FOV: 45 degrees — 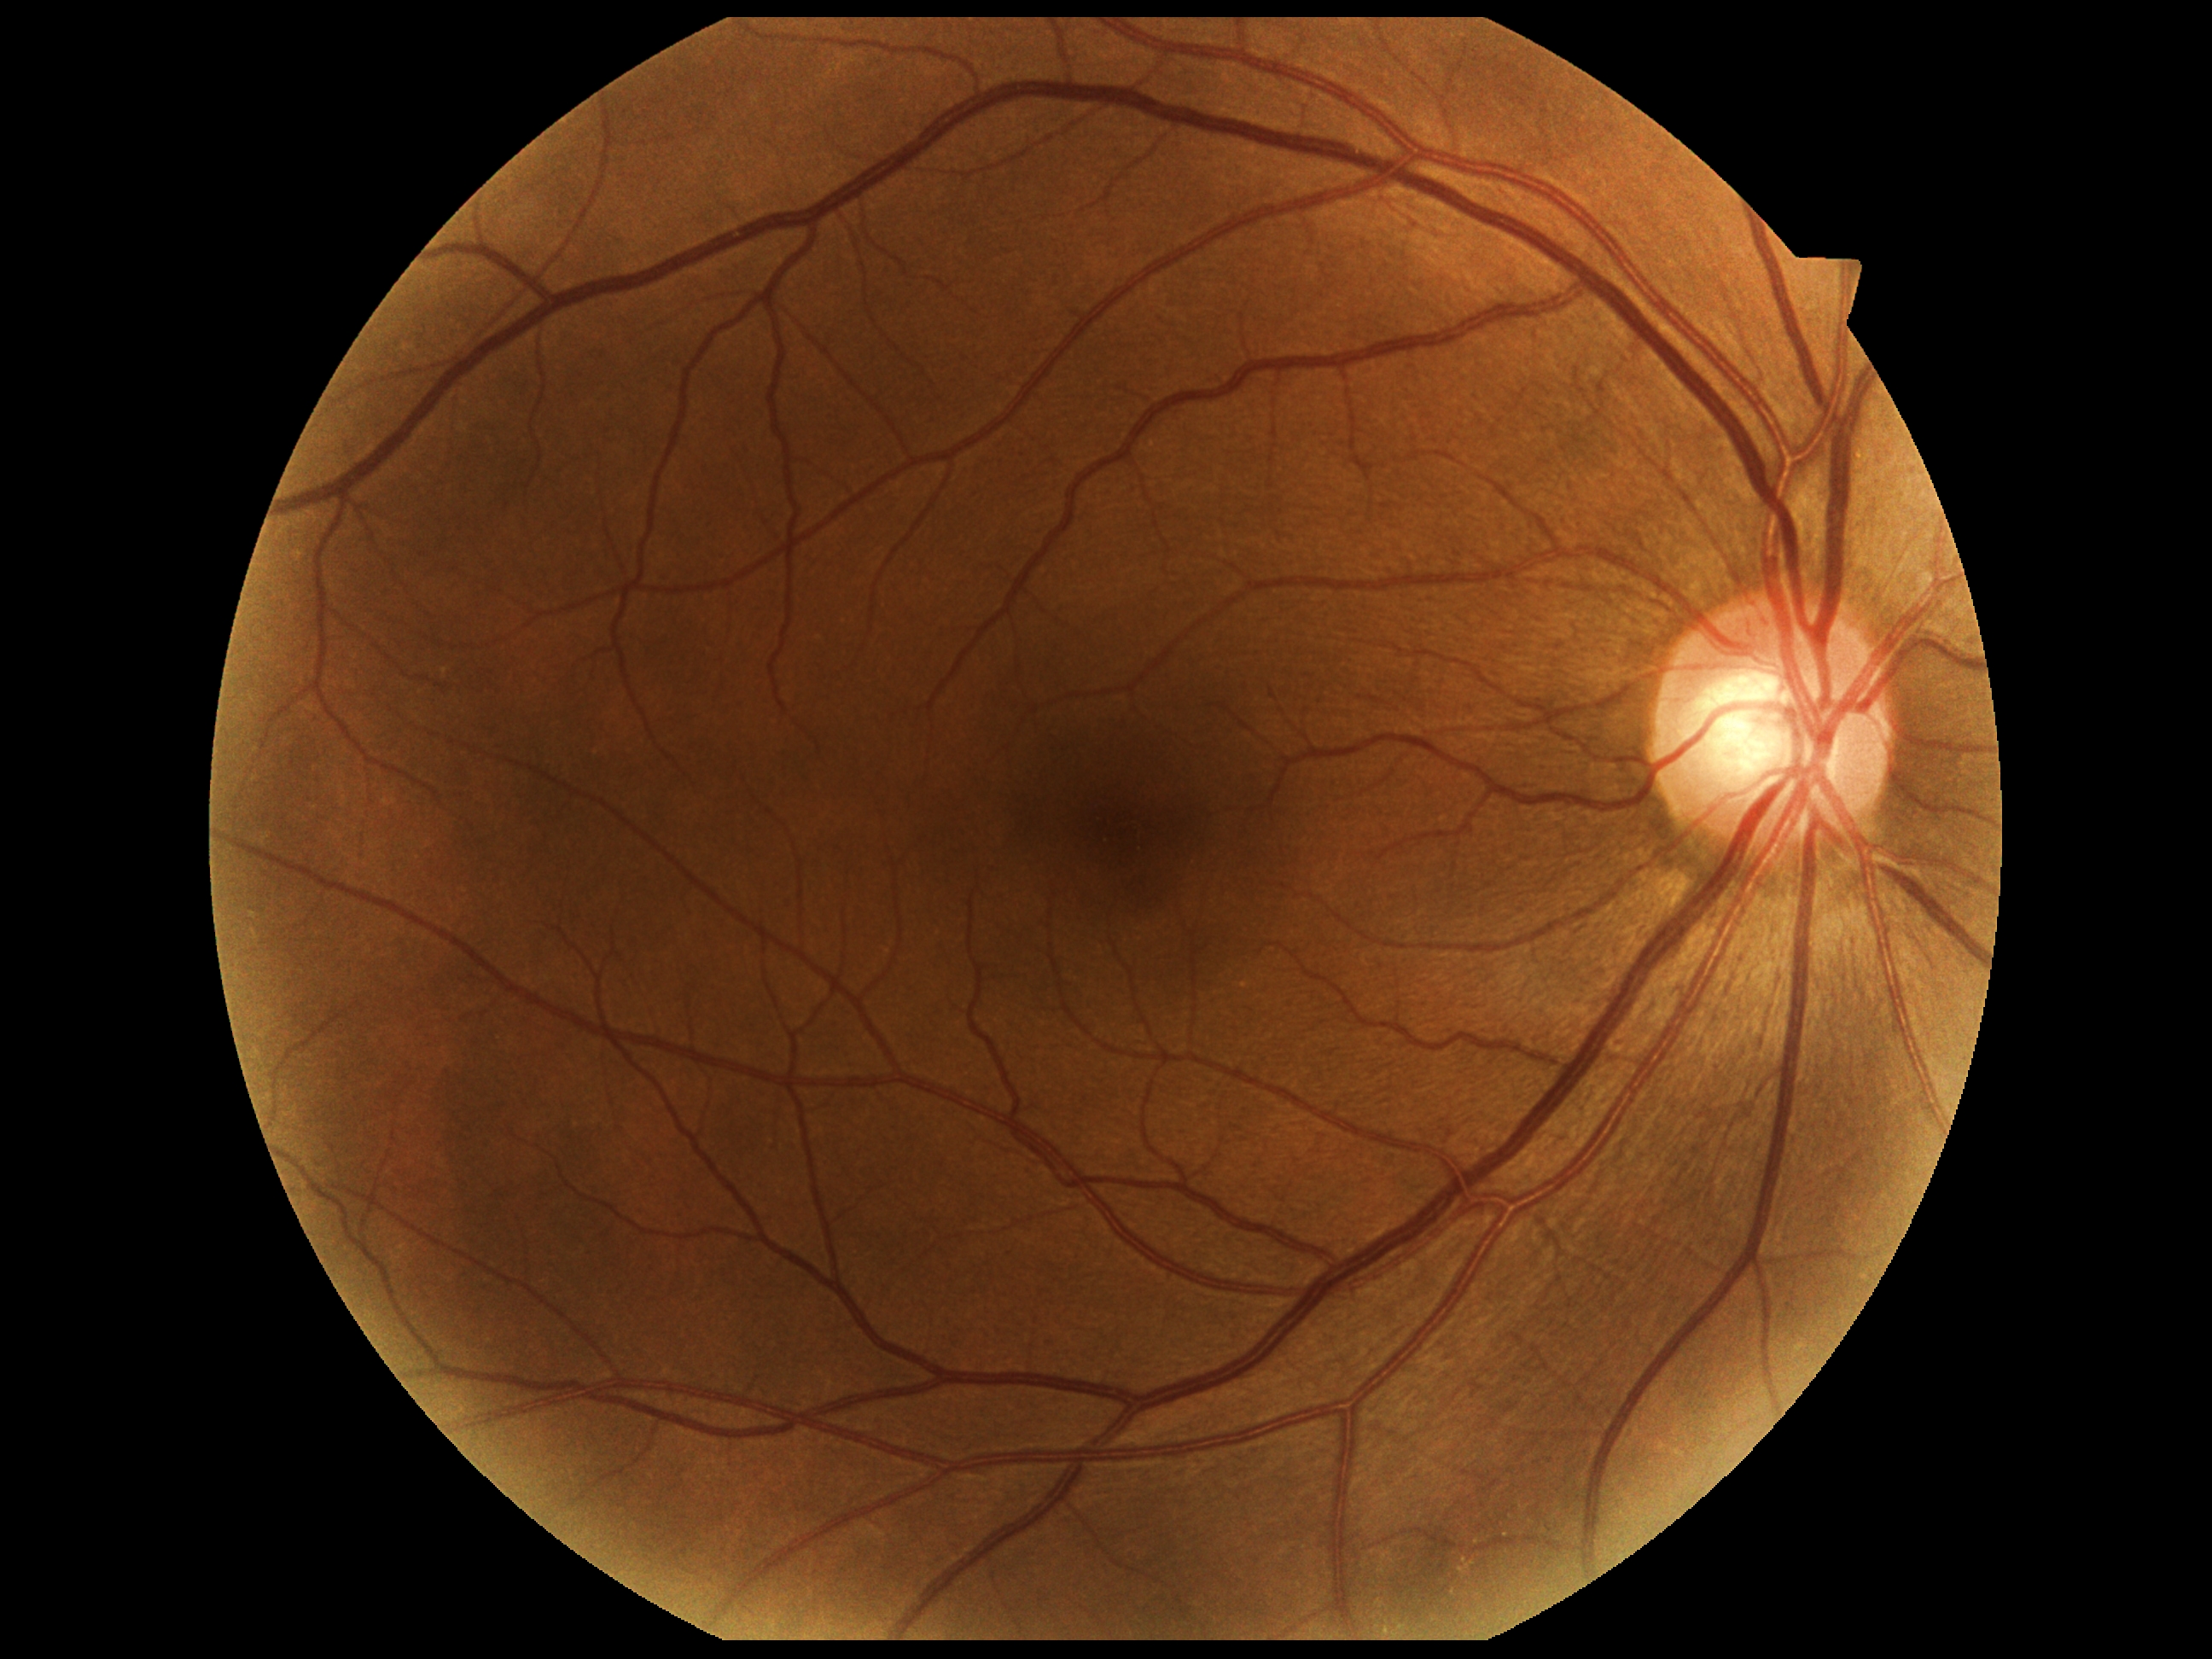

DR: 0.